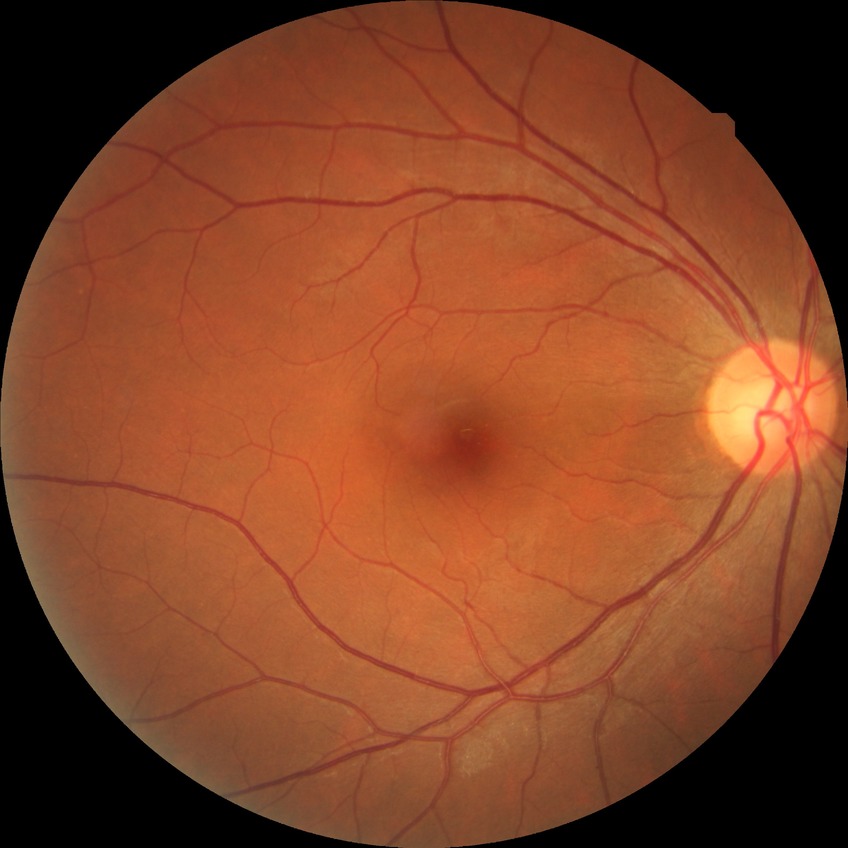

diabetic retinopathy (DR) = NDR (no diabetic retinopathy).